Nonmydriatic · 45° FOV: 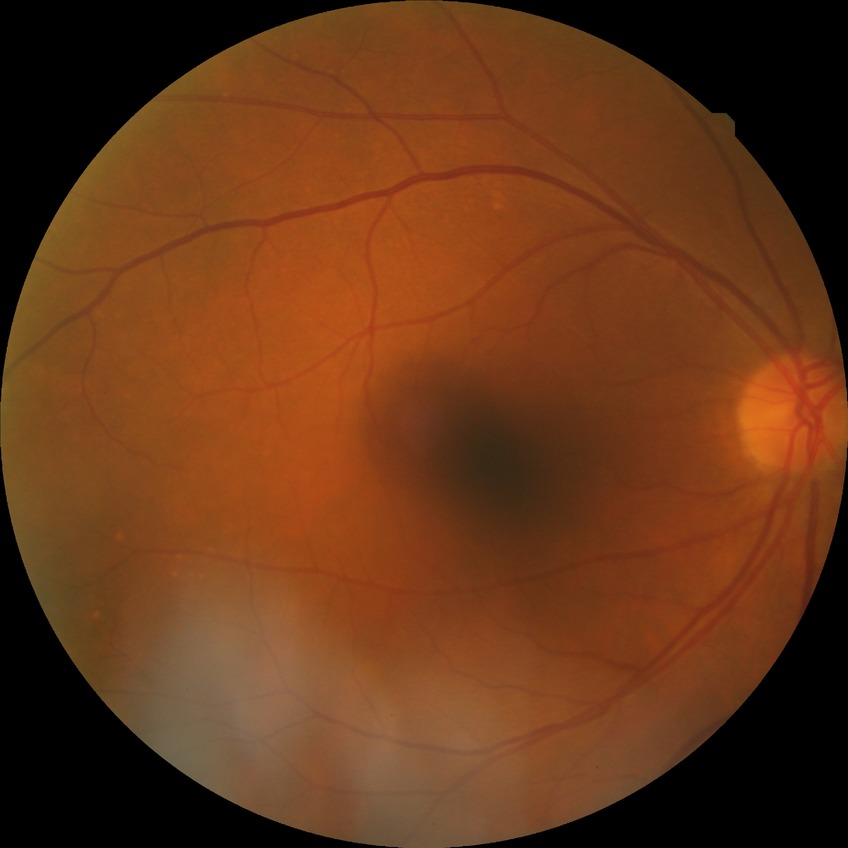
Diabetic retinopathy (DR) is NDR (no diabetic retinopathy).